Infant wide-field retinal image: 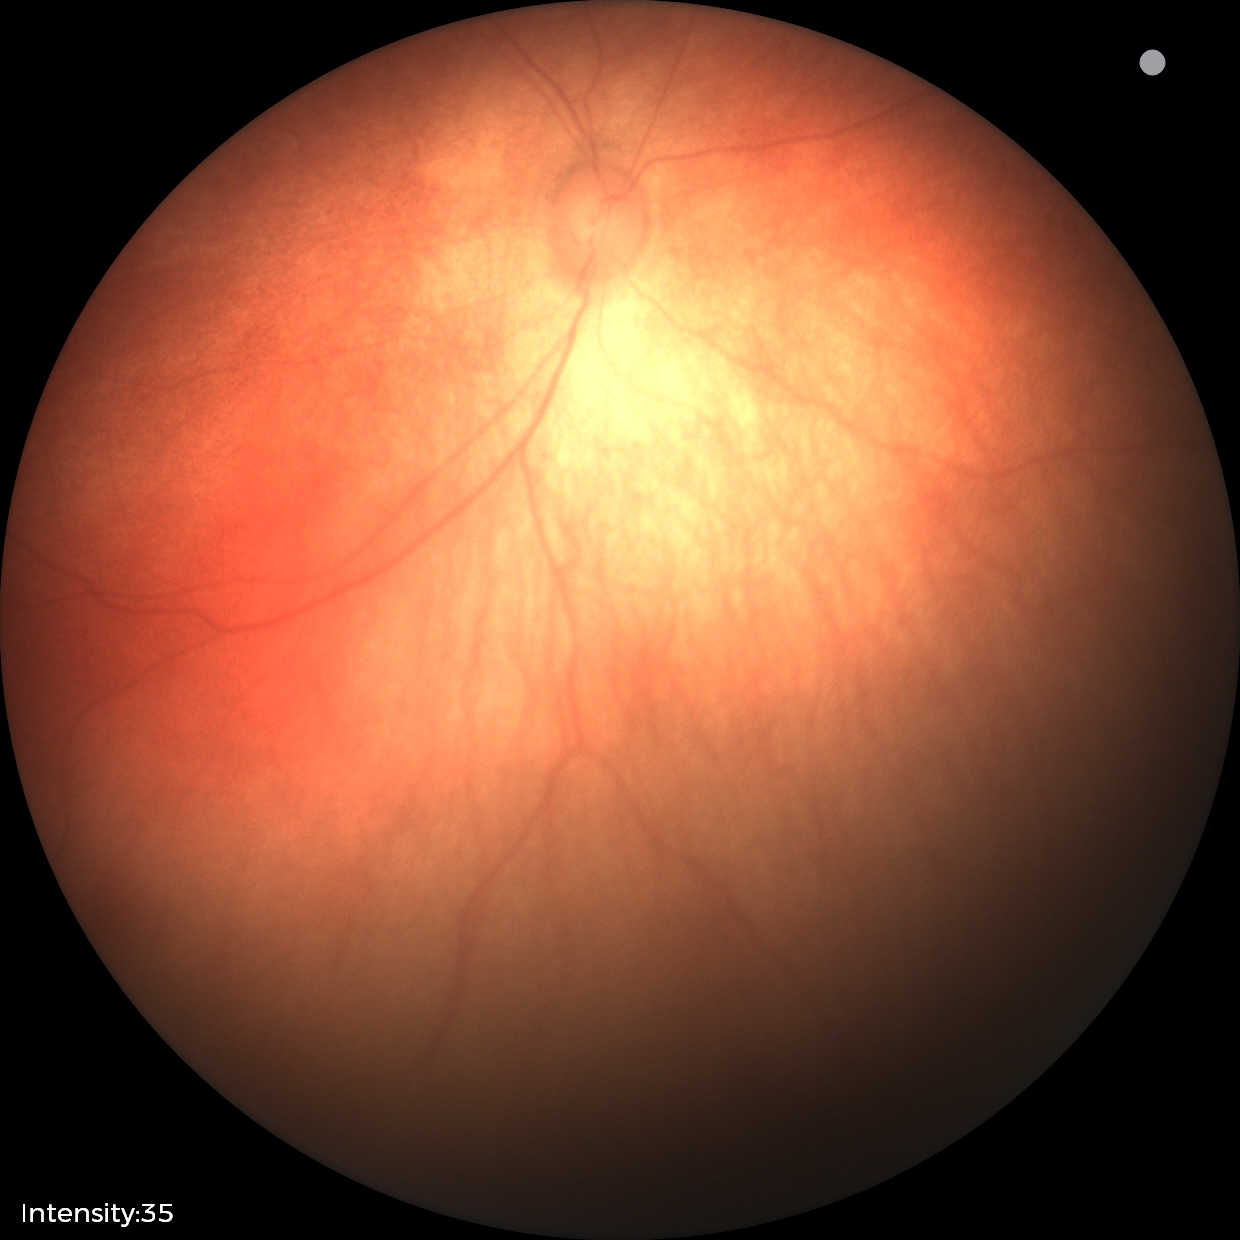

Assessment: no abnormal retinal findings.